Captured with the Clarity RetCam 3 (130° field of view); pediatric retinal photograph (wide-field); image size 640x480: 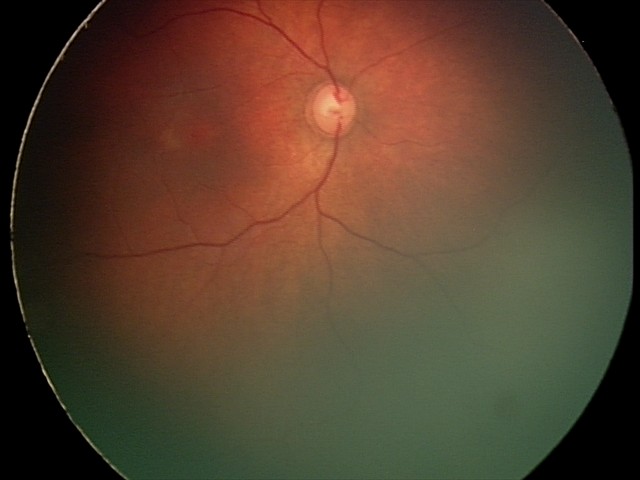

Examination with physiological retinal findings.